DR severity per modified Davis staging · 848x848.
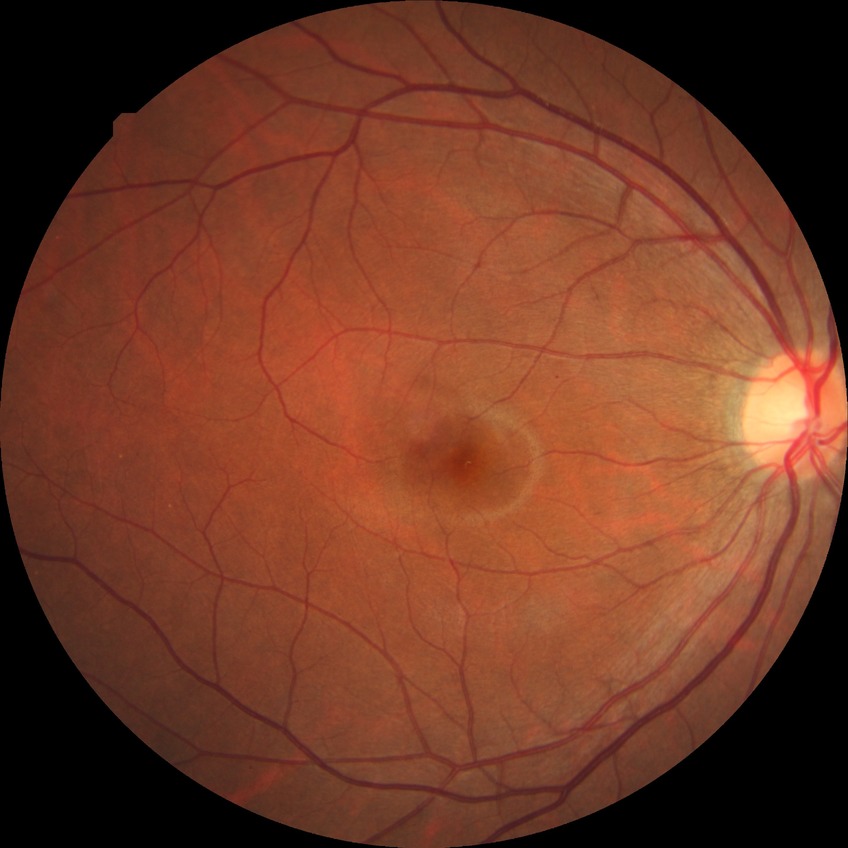
Diabetic retinopathy (DR) is NDR (no diabetic retinopathy).